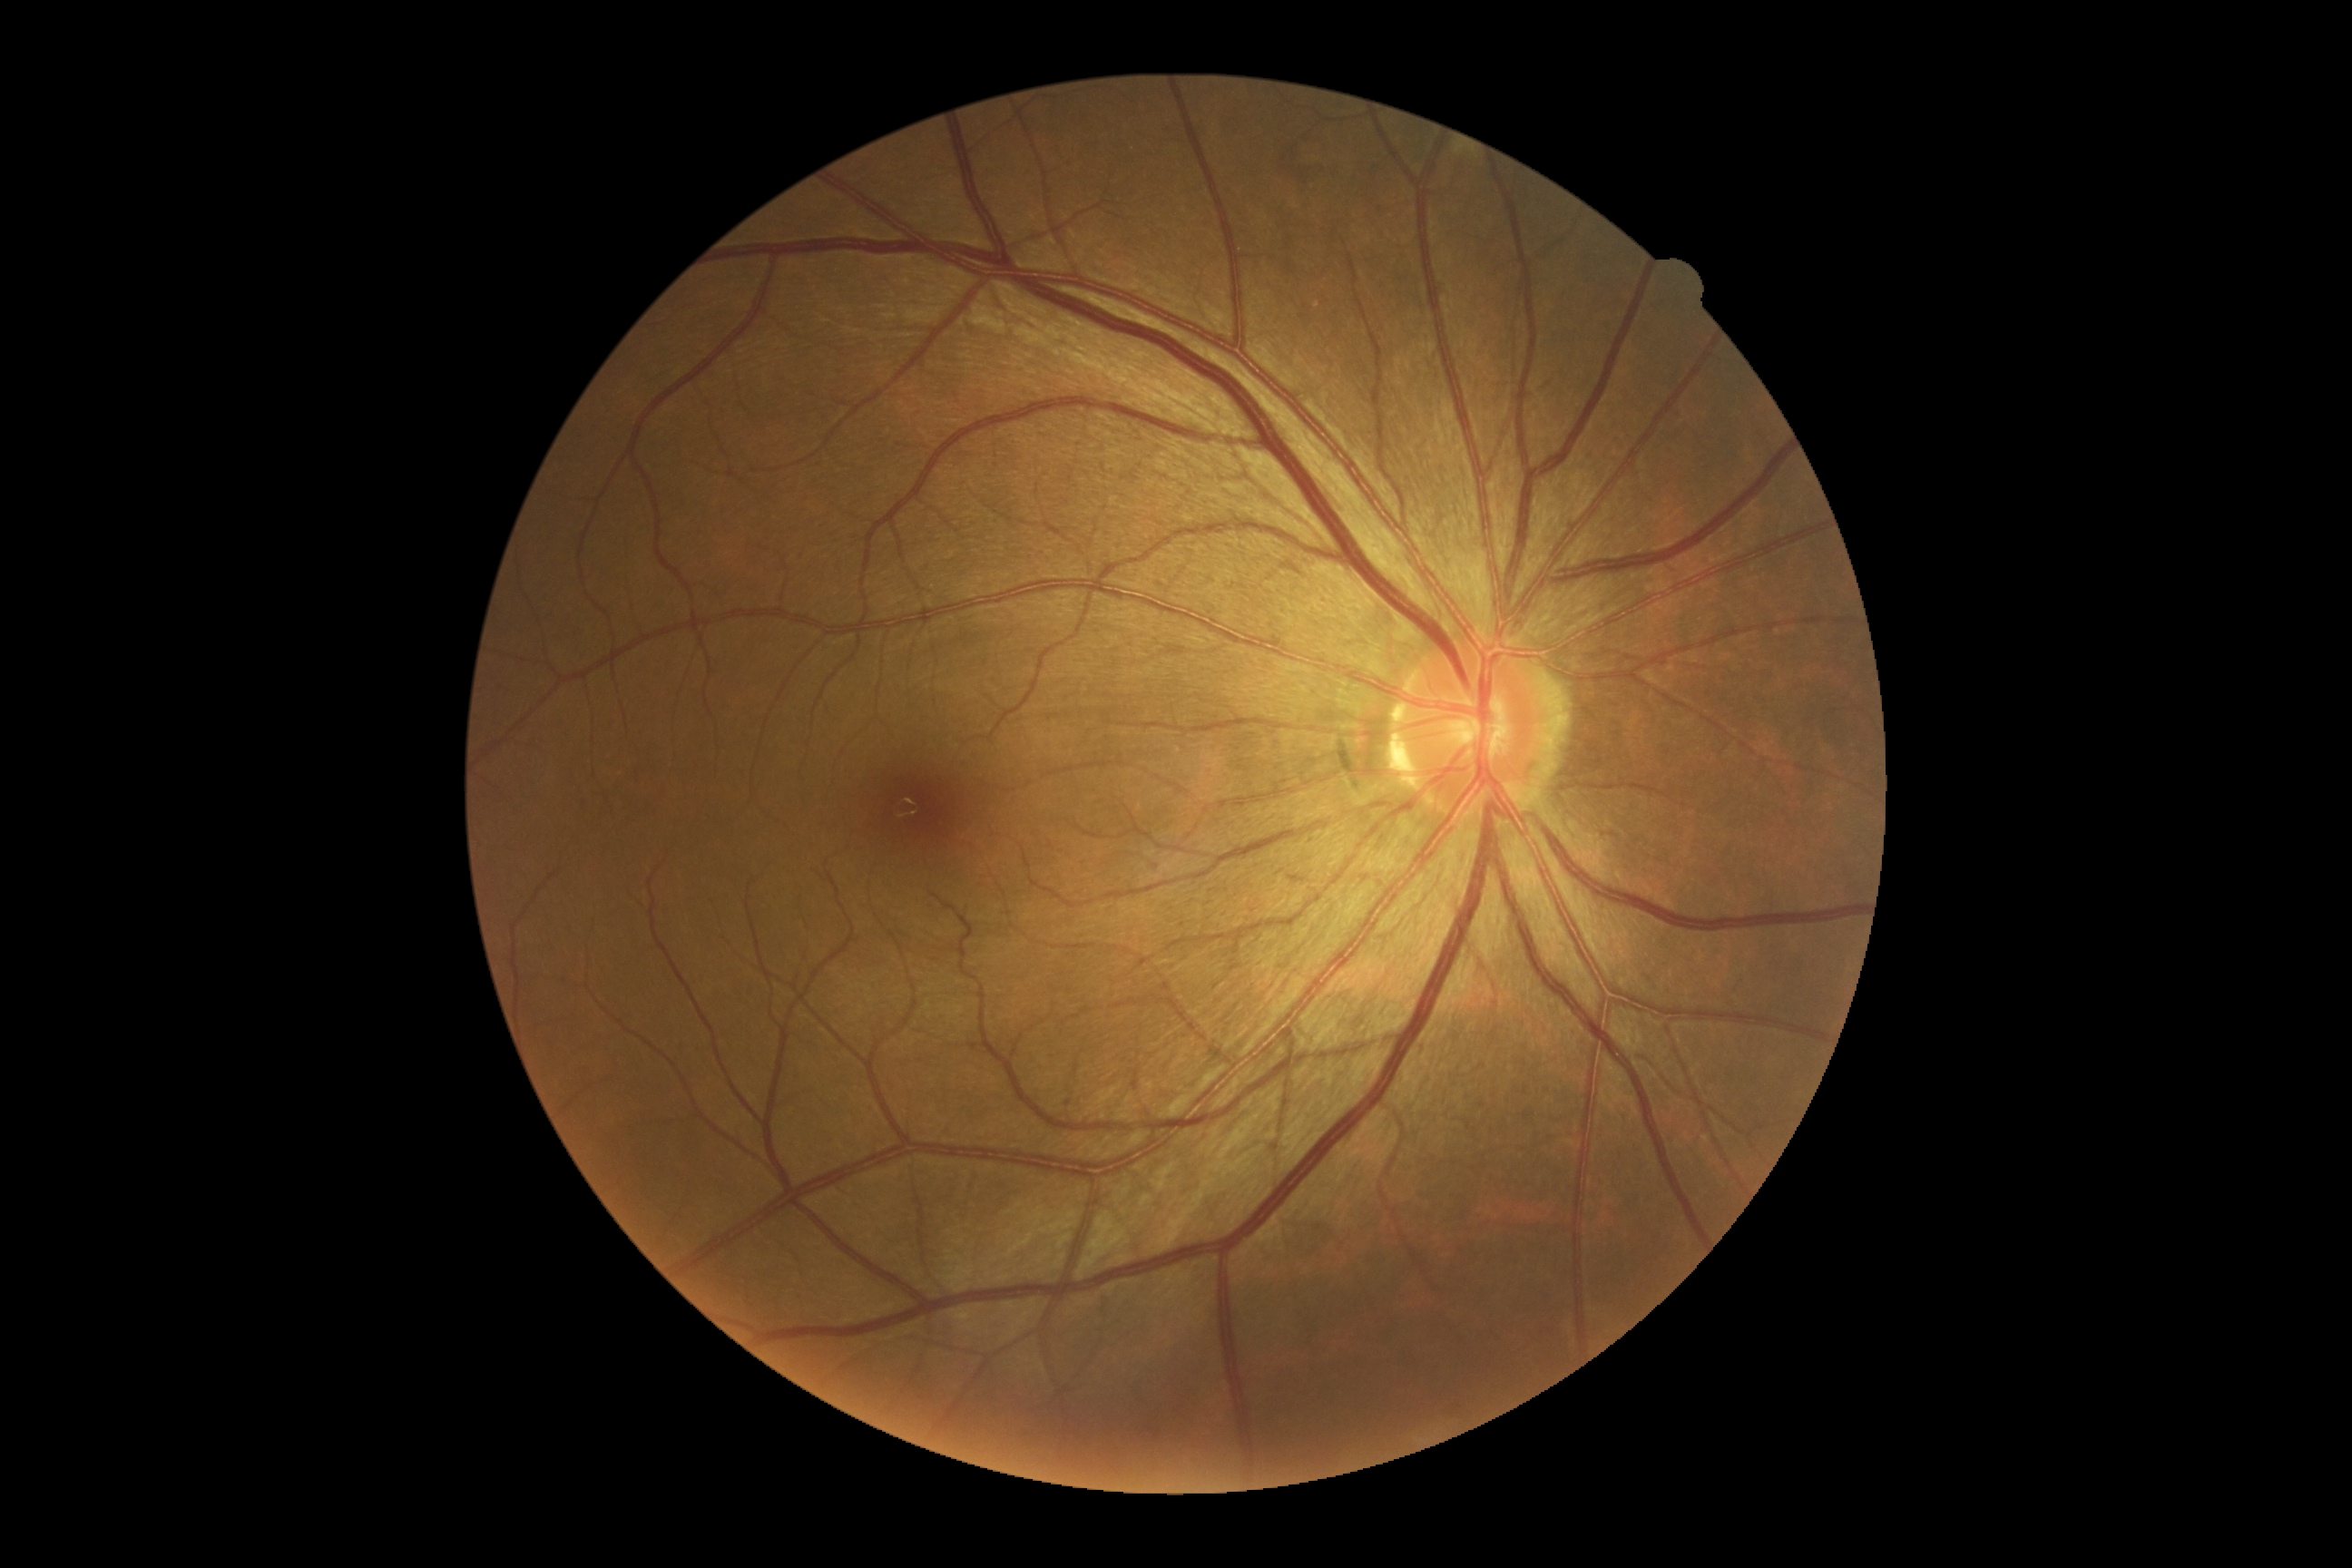

DR severity: grade 0.